Fundus photo:
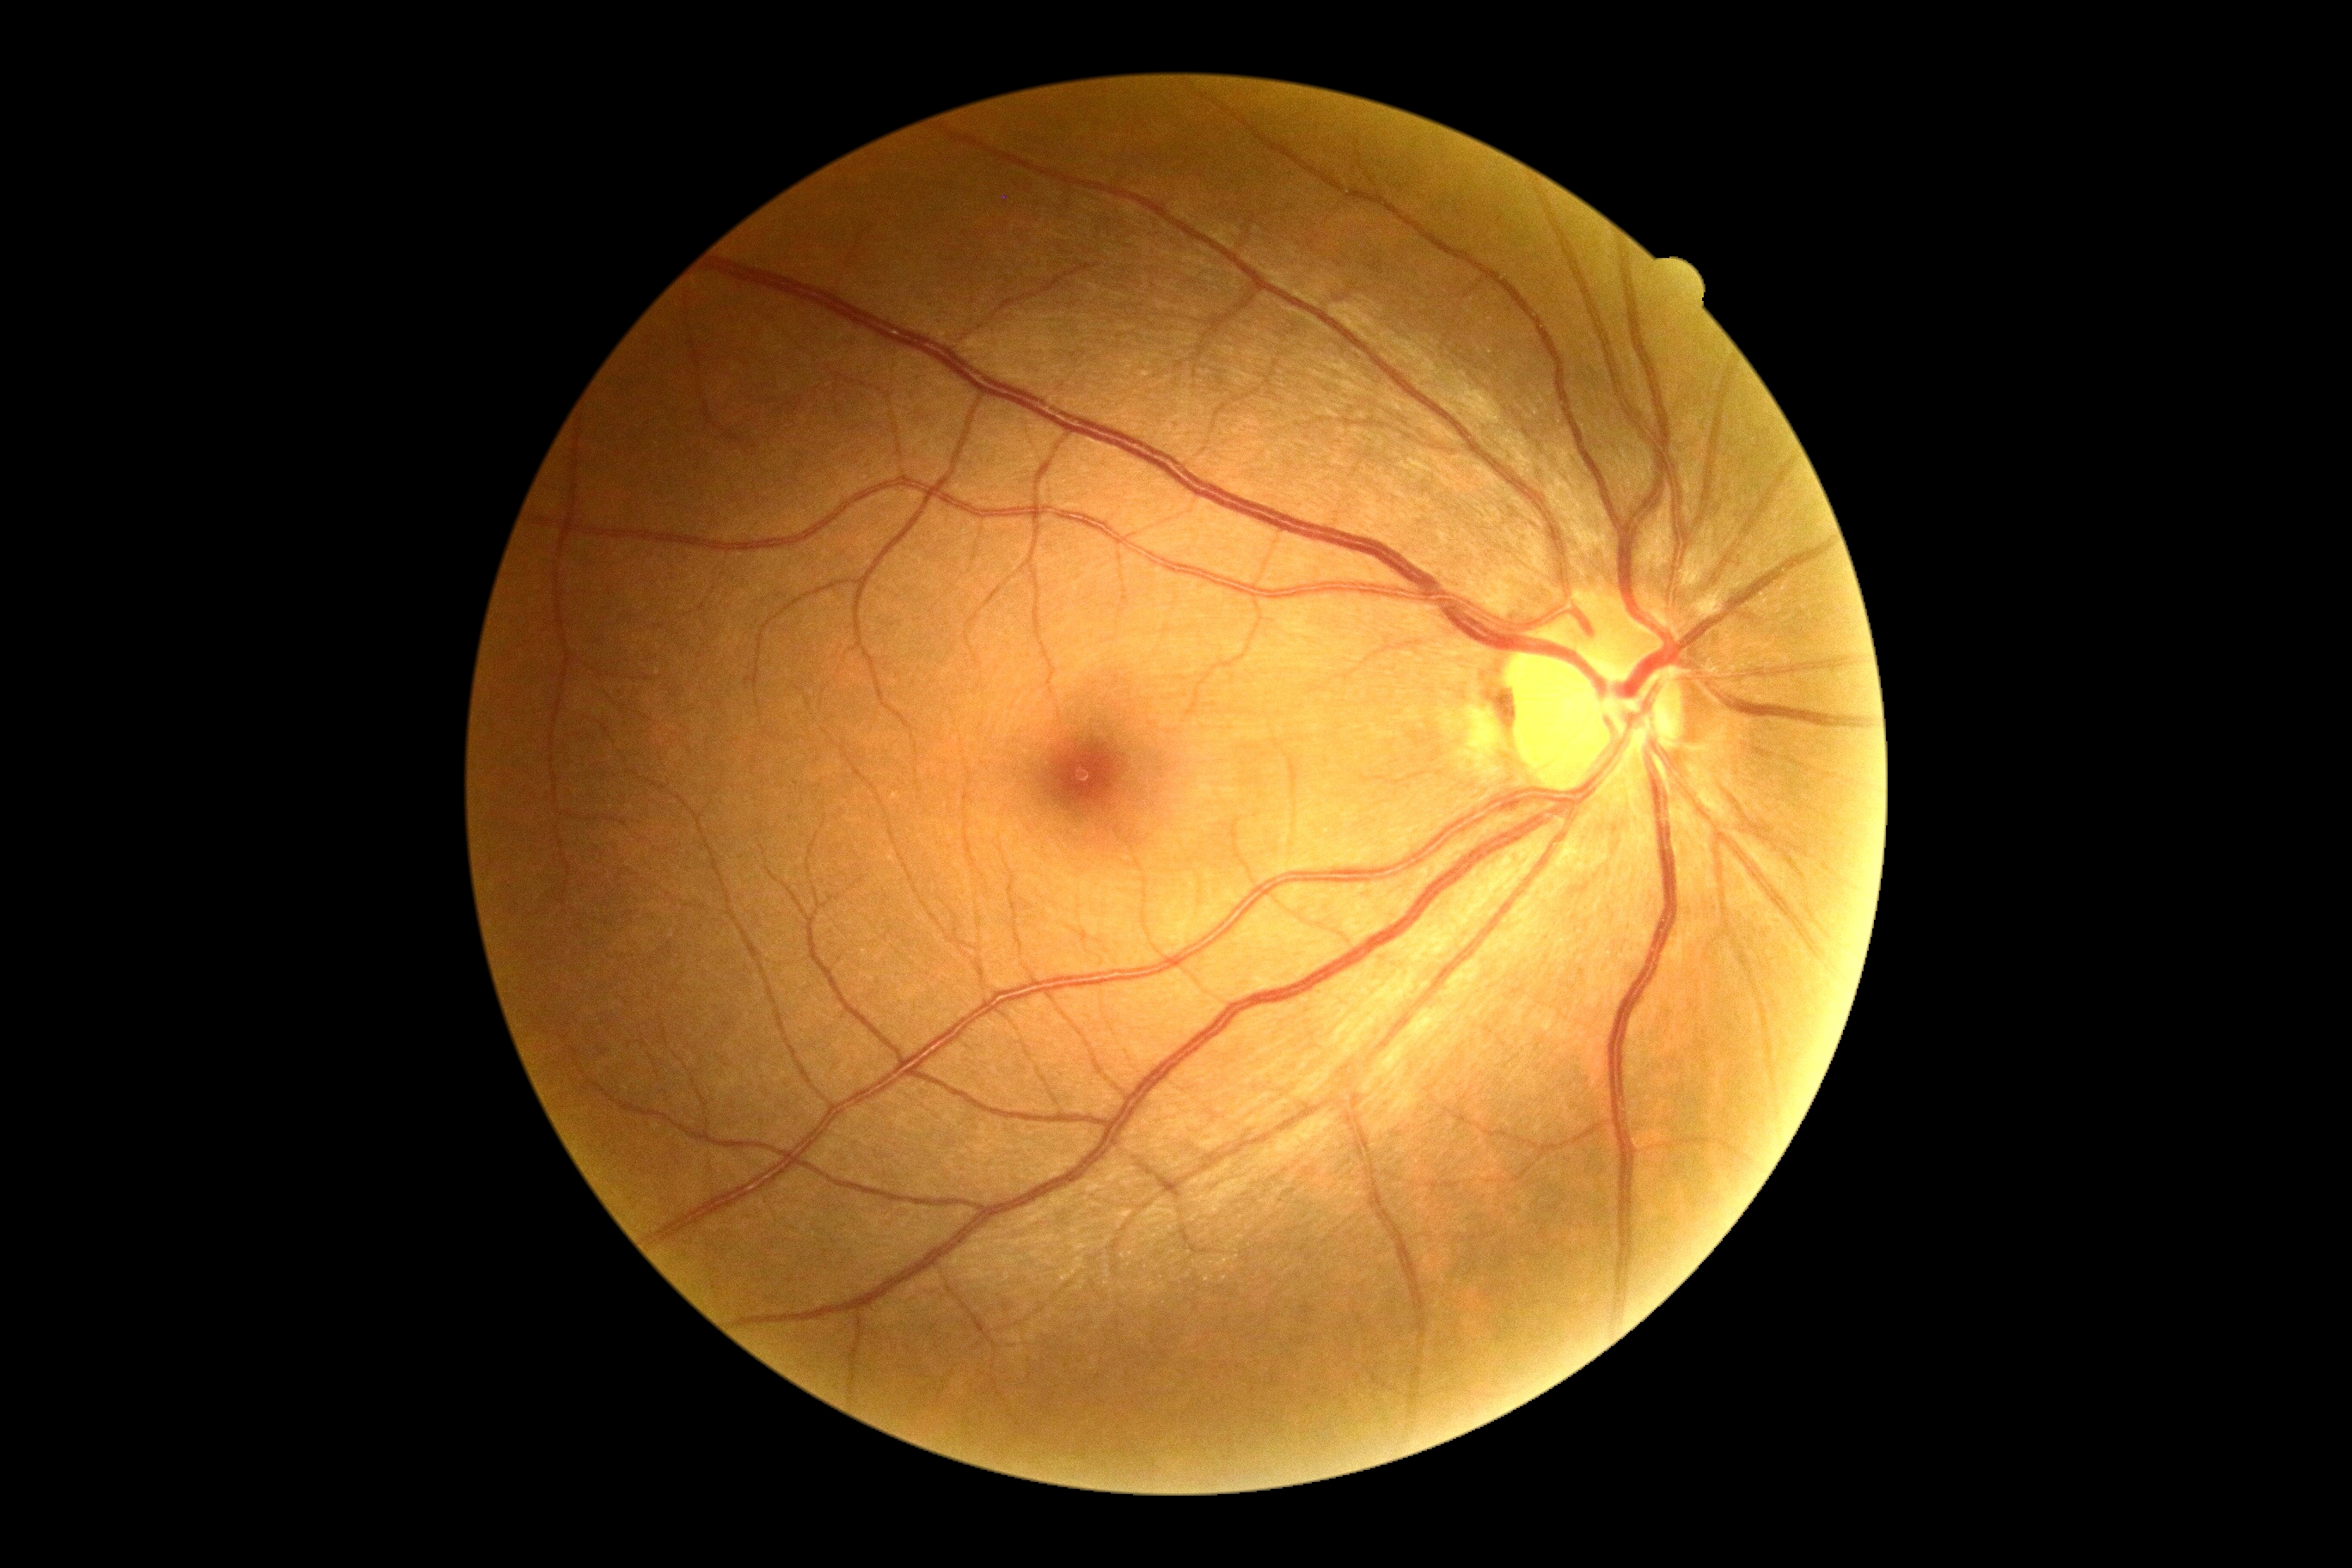

Retinopathy grade: no apparent diabetic retinopathy (0).